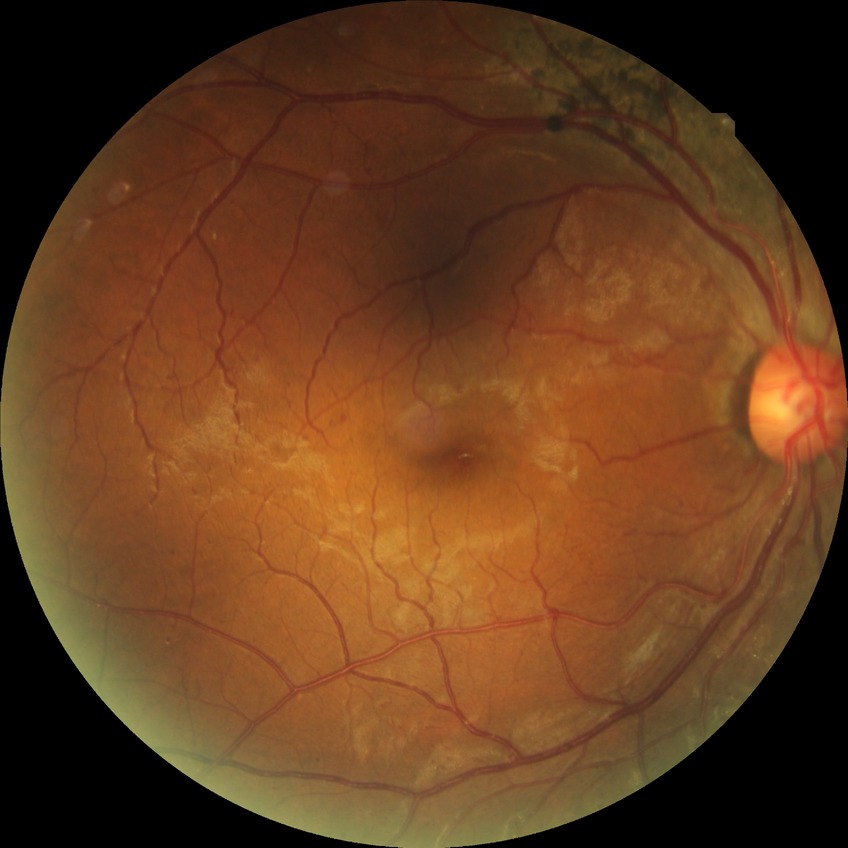
DR grade@PPDR; DR class@non-proliferative diabetic retinopathy.